1240x1240px; infant wide-field fundus photograph.
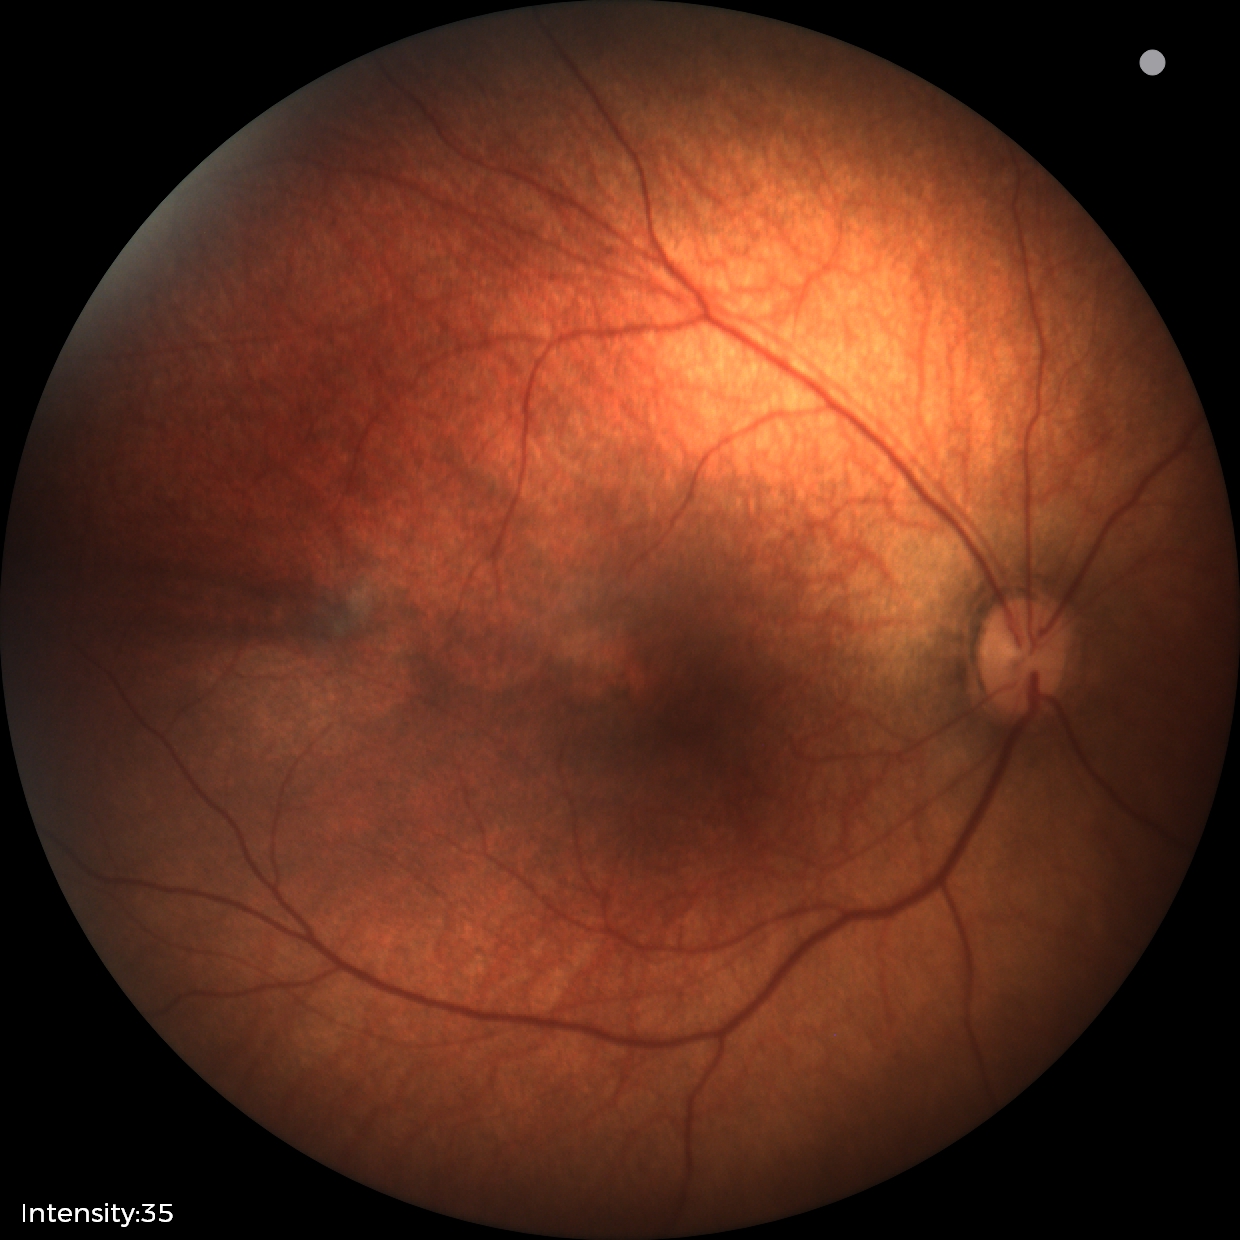
No retinal pathology identified on screening.